FOV: 45 degrees.
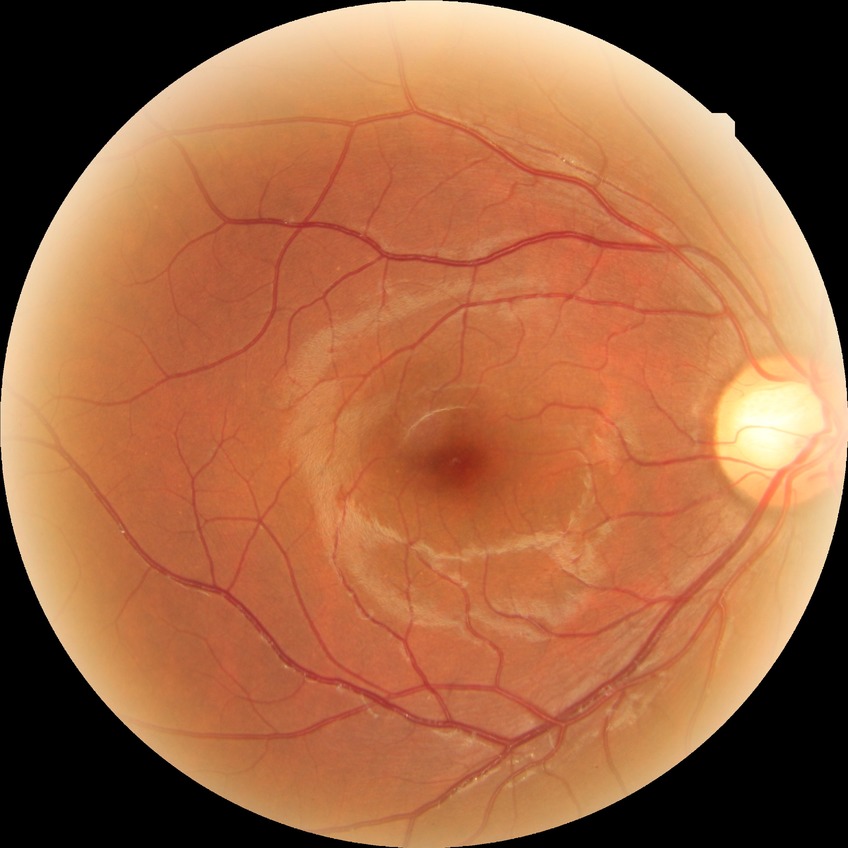

diabetic retinopathy (DR) = NDR (no diabetic retinopathy)